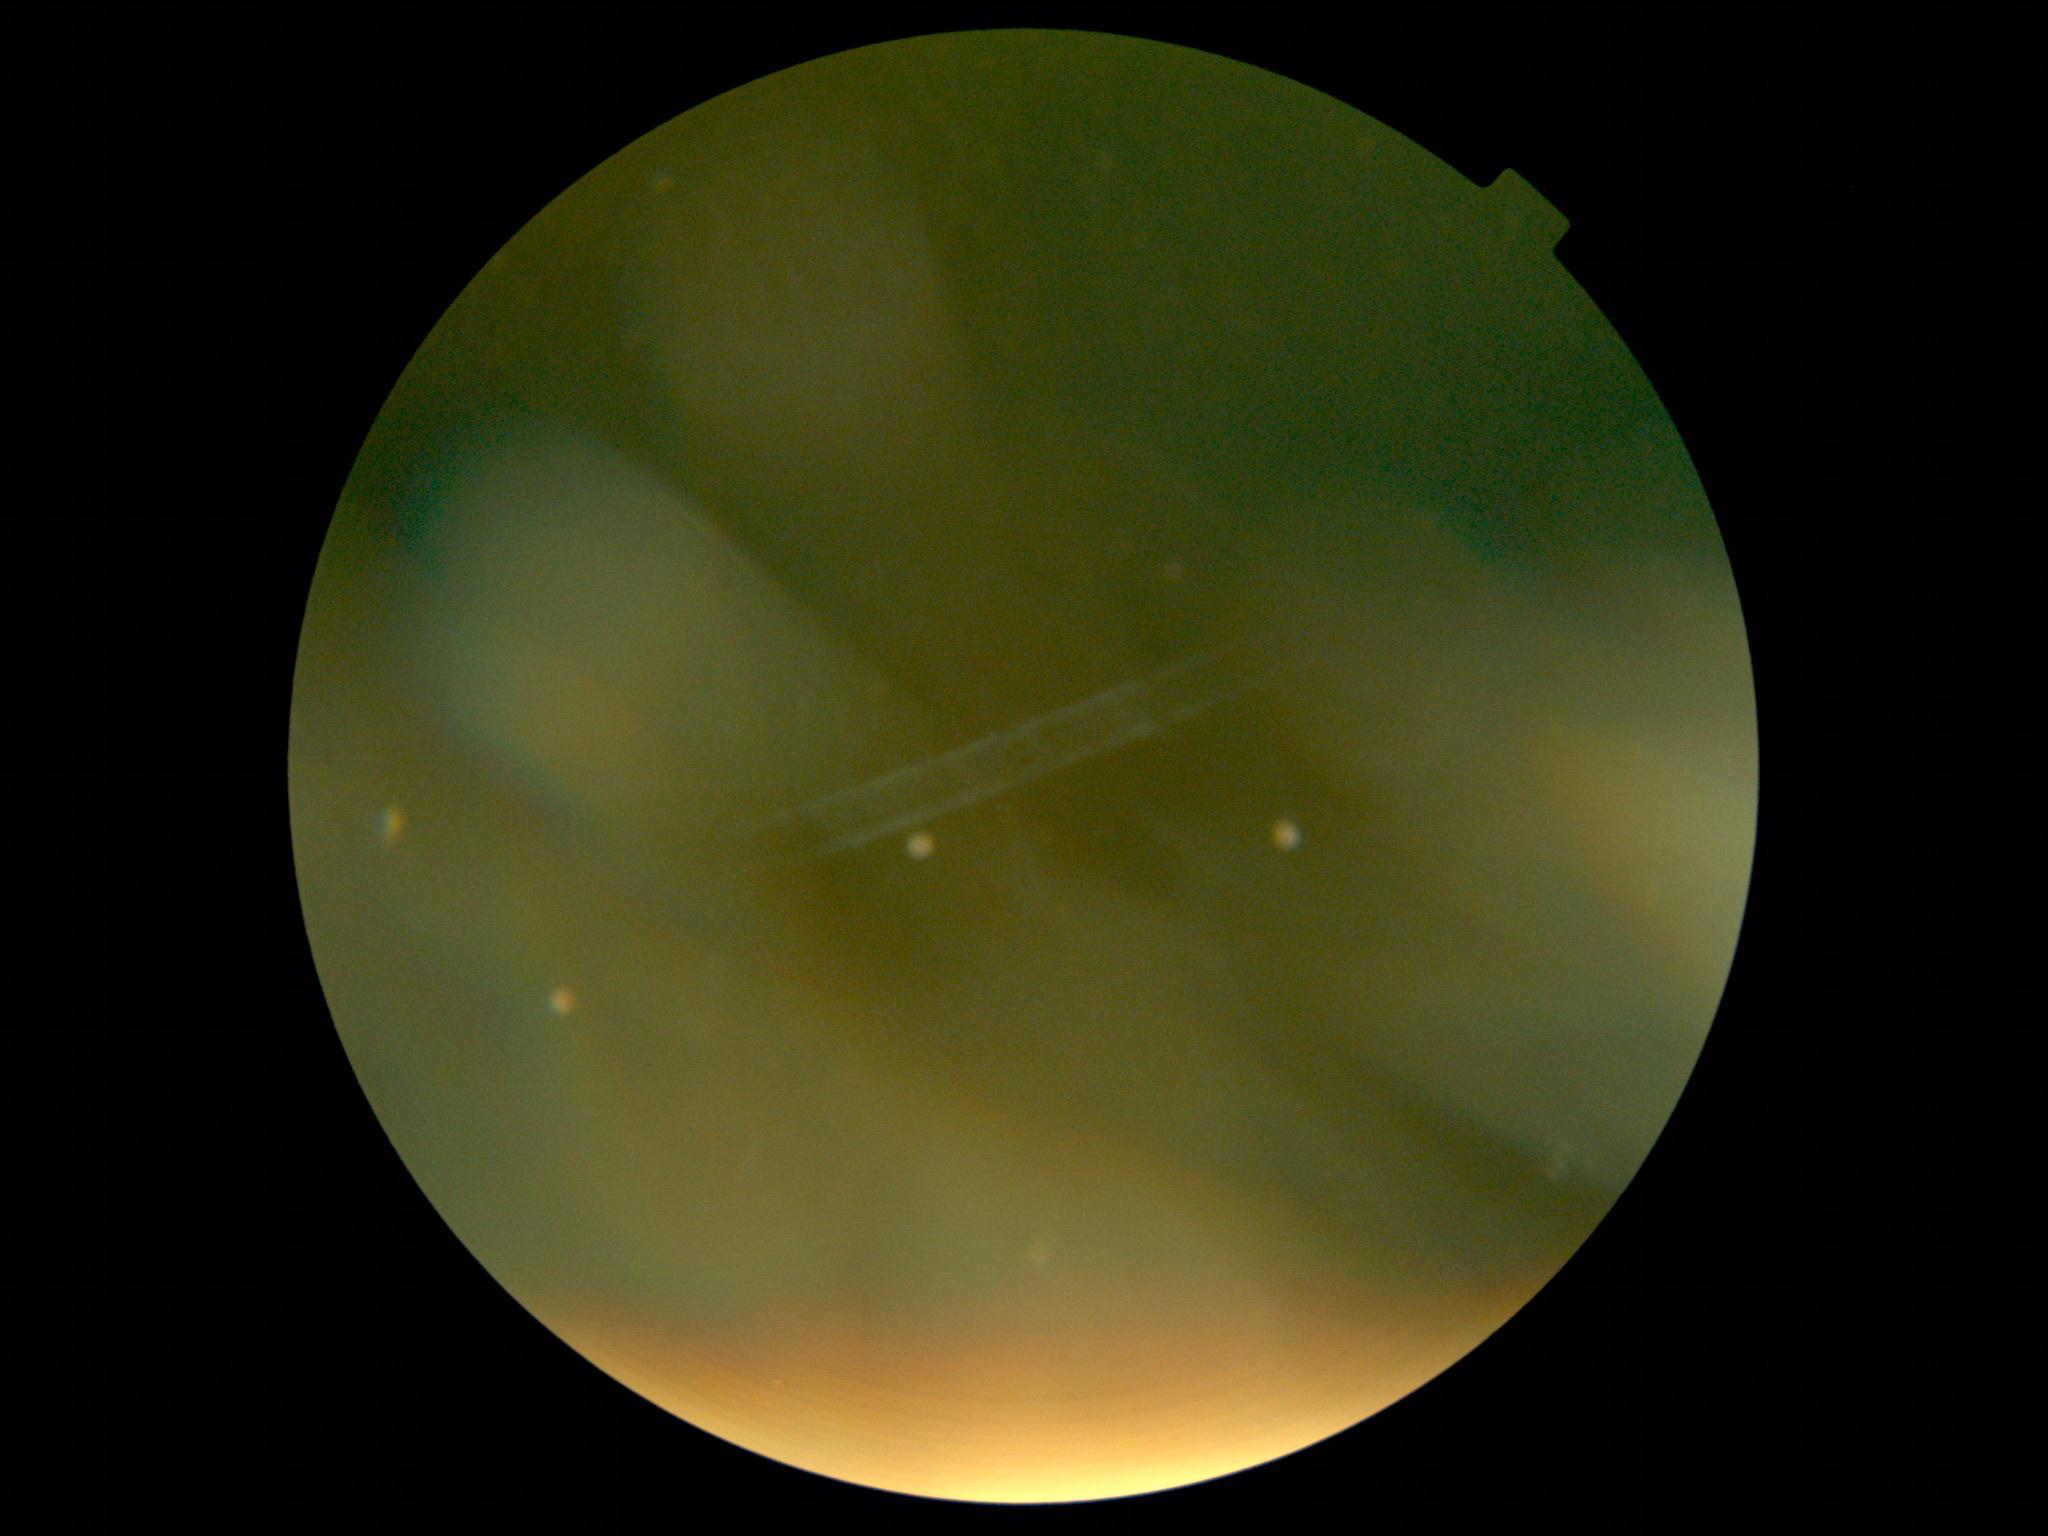

dr_grade: ungradable due to poor image quality
quality: too poor for DR grading